Captured without pupil dilation; 240 x 240 pixels — 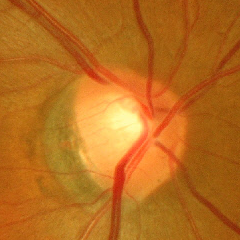

Glaucomatous changes are present. Glaucoma stage = advanced-stage glaucoma.